Modified Davis grading — 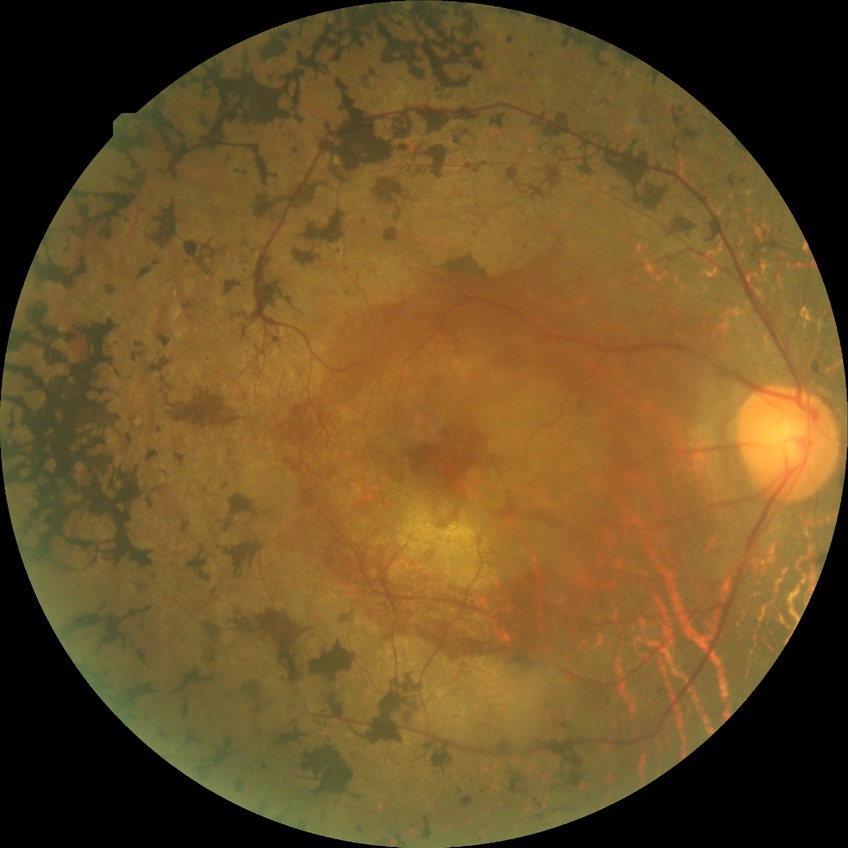
{
  "davis_grade": "no diabetic retinopathy"
}